CFP.
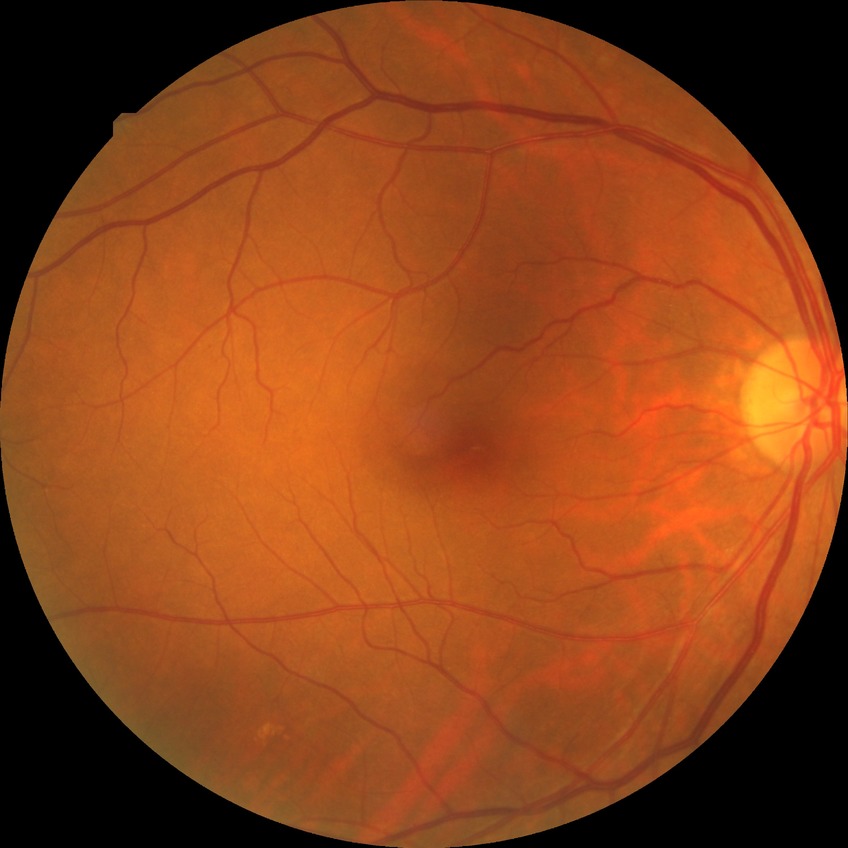
Davis DR grade: NDR.